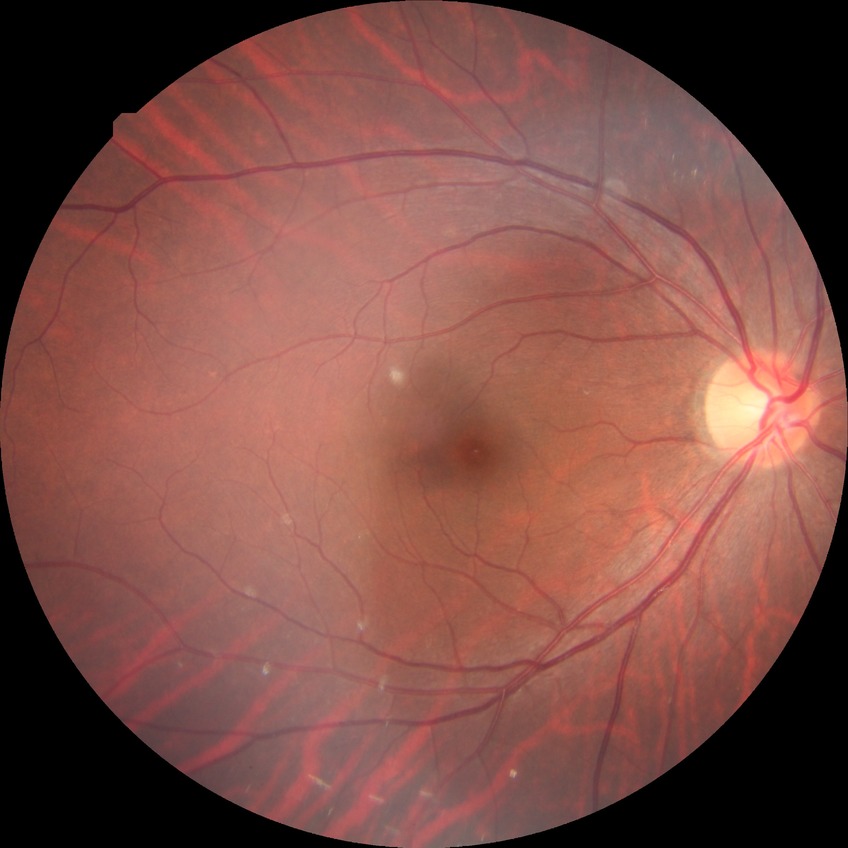

No signs of diabetic retinopathy. DR stage is NDR.